45° FOV:
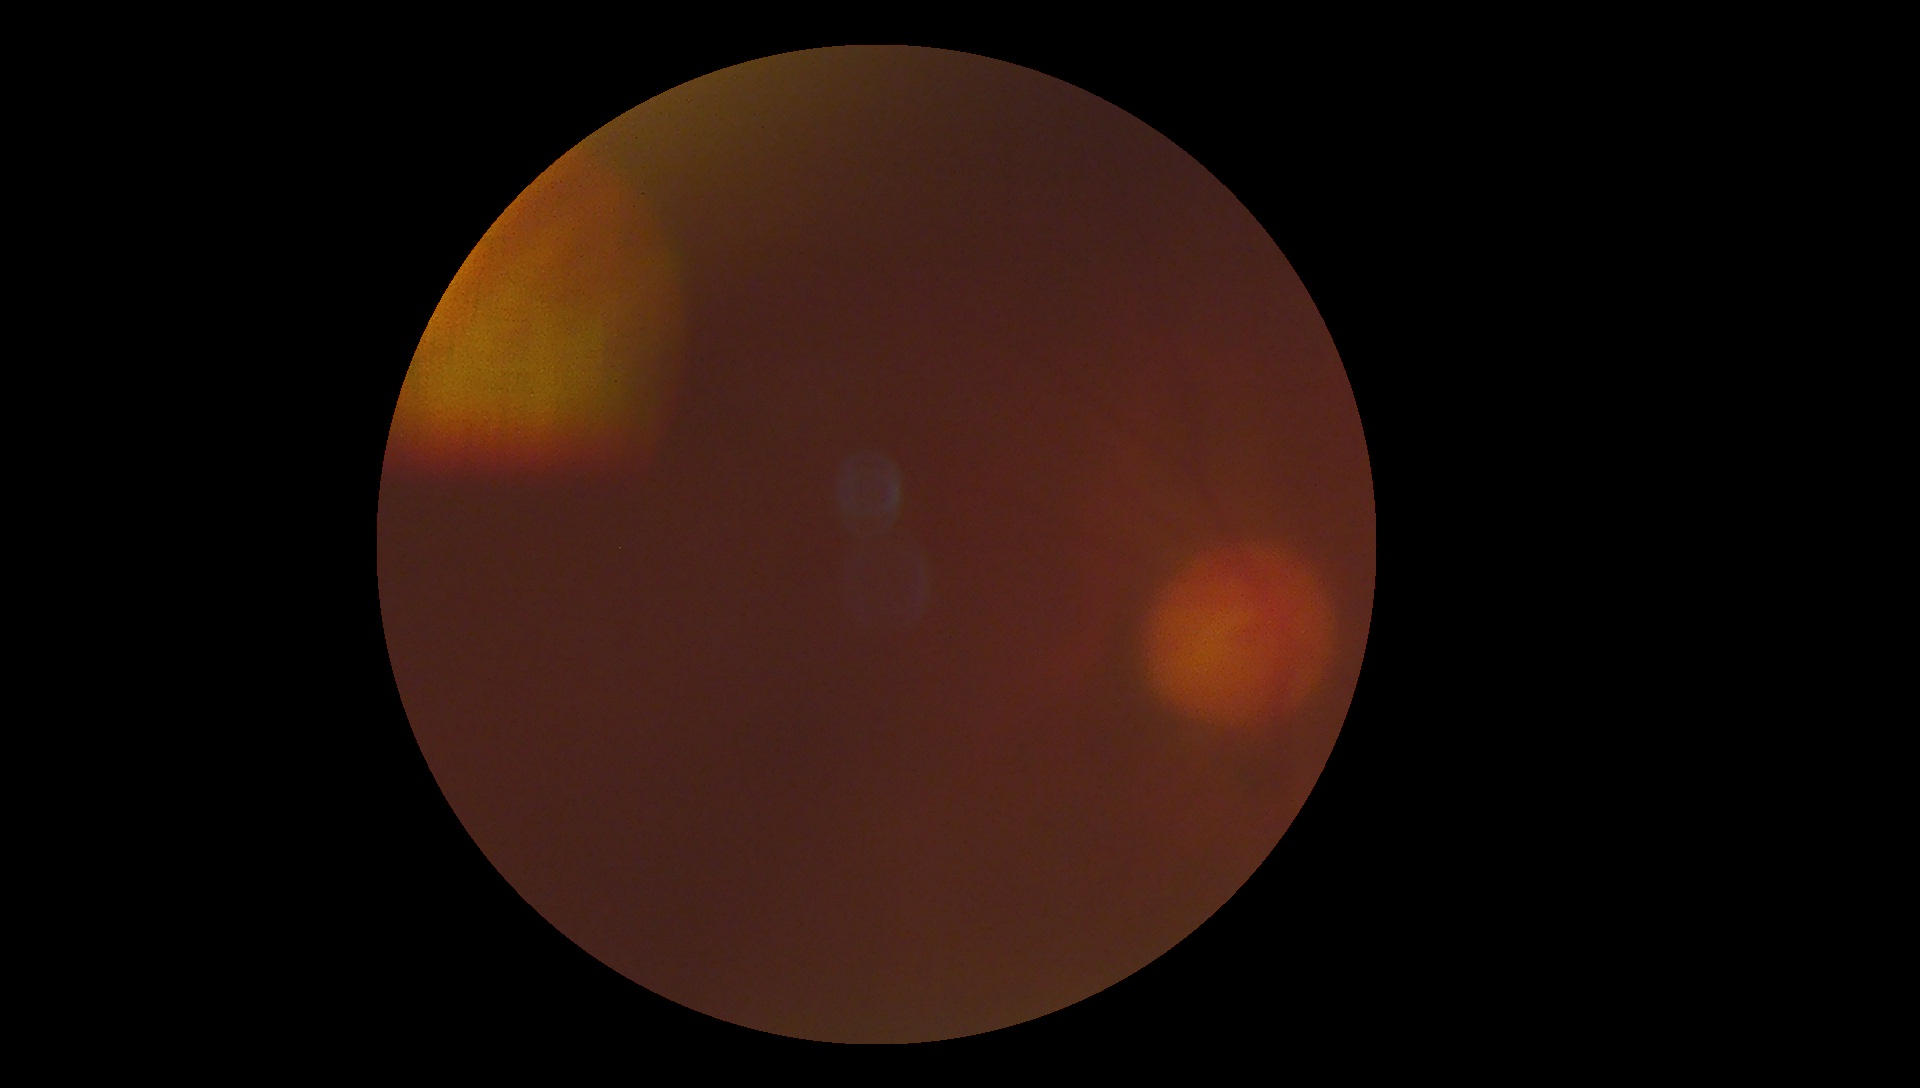

DR grade is ungradable due to poor image quality. Image quality is insufficient for diabetic retinopathy assessment.